RetCam wide-field infant fundus image: 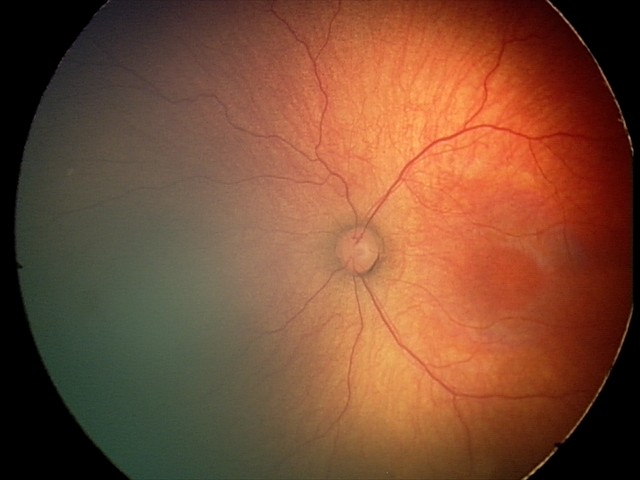

Series diagnosed as retinopathy of prematurity (ROP) stage 2.